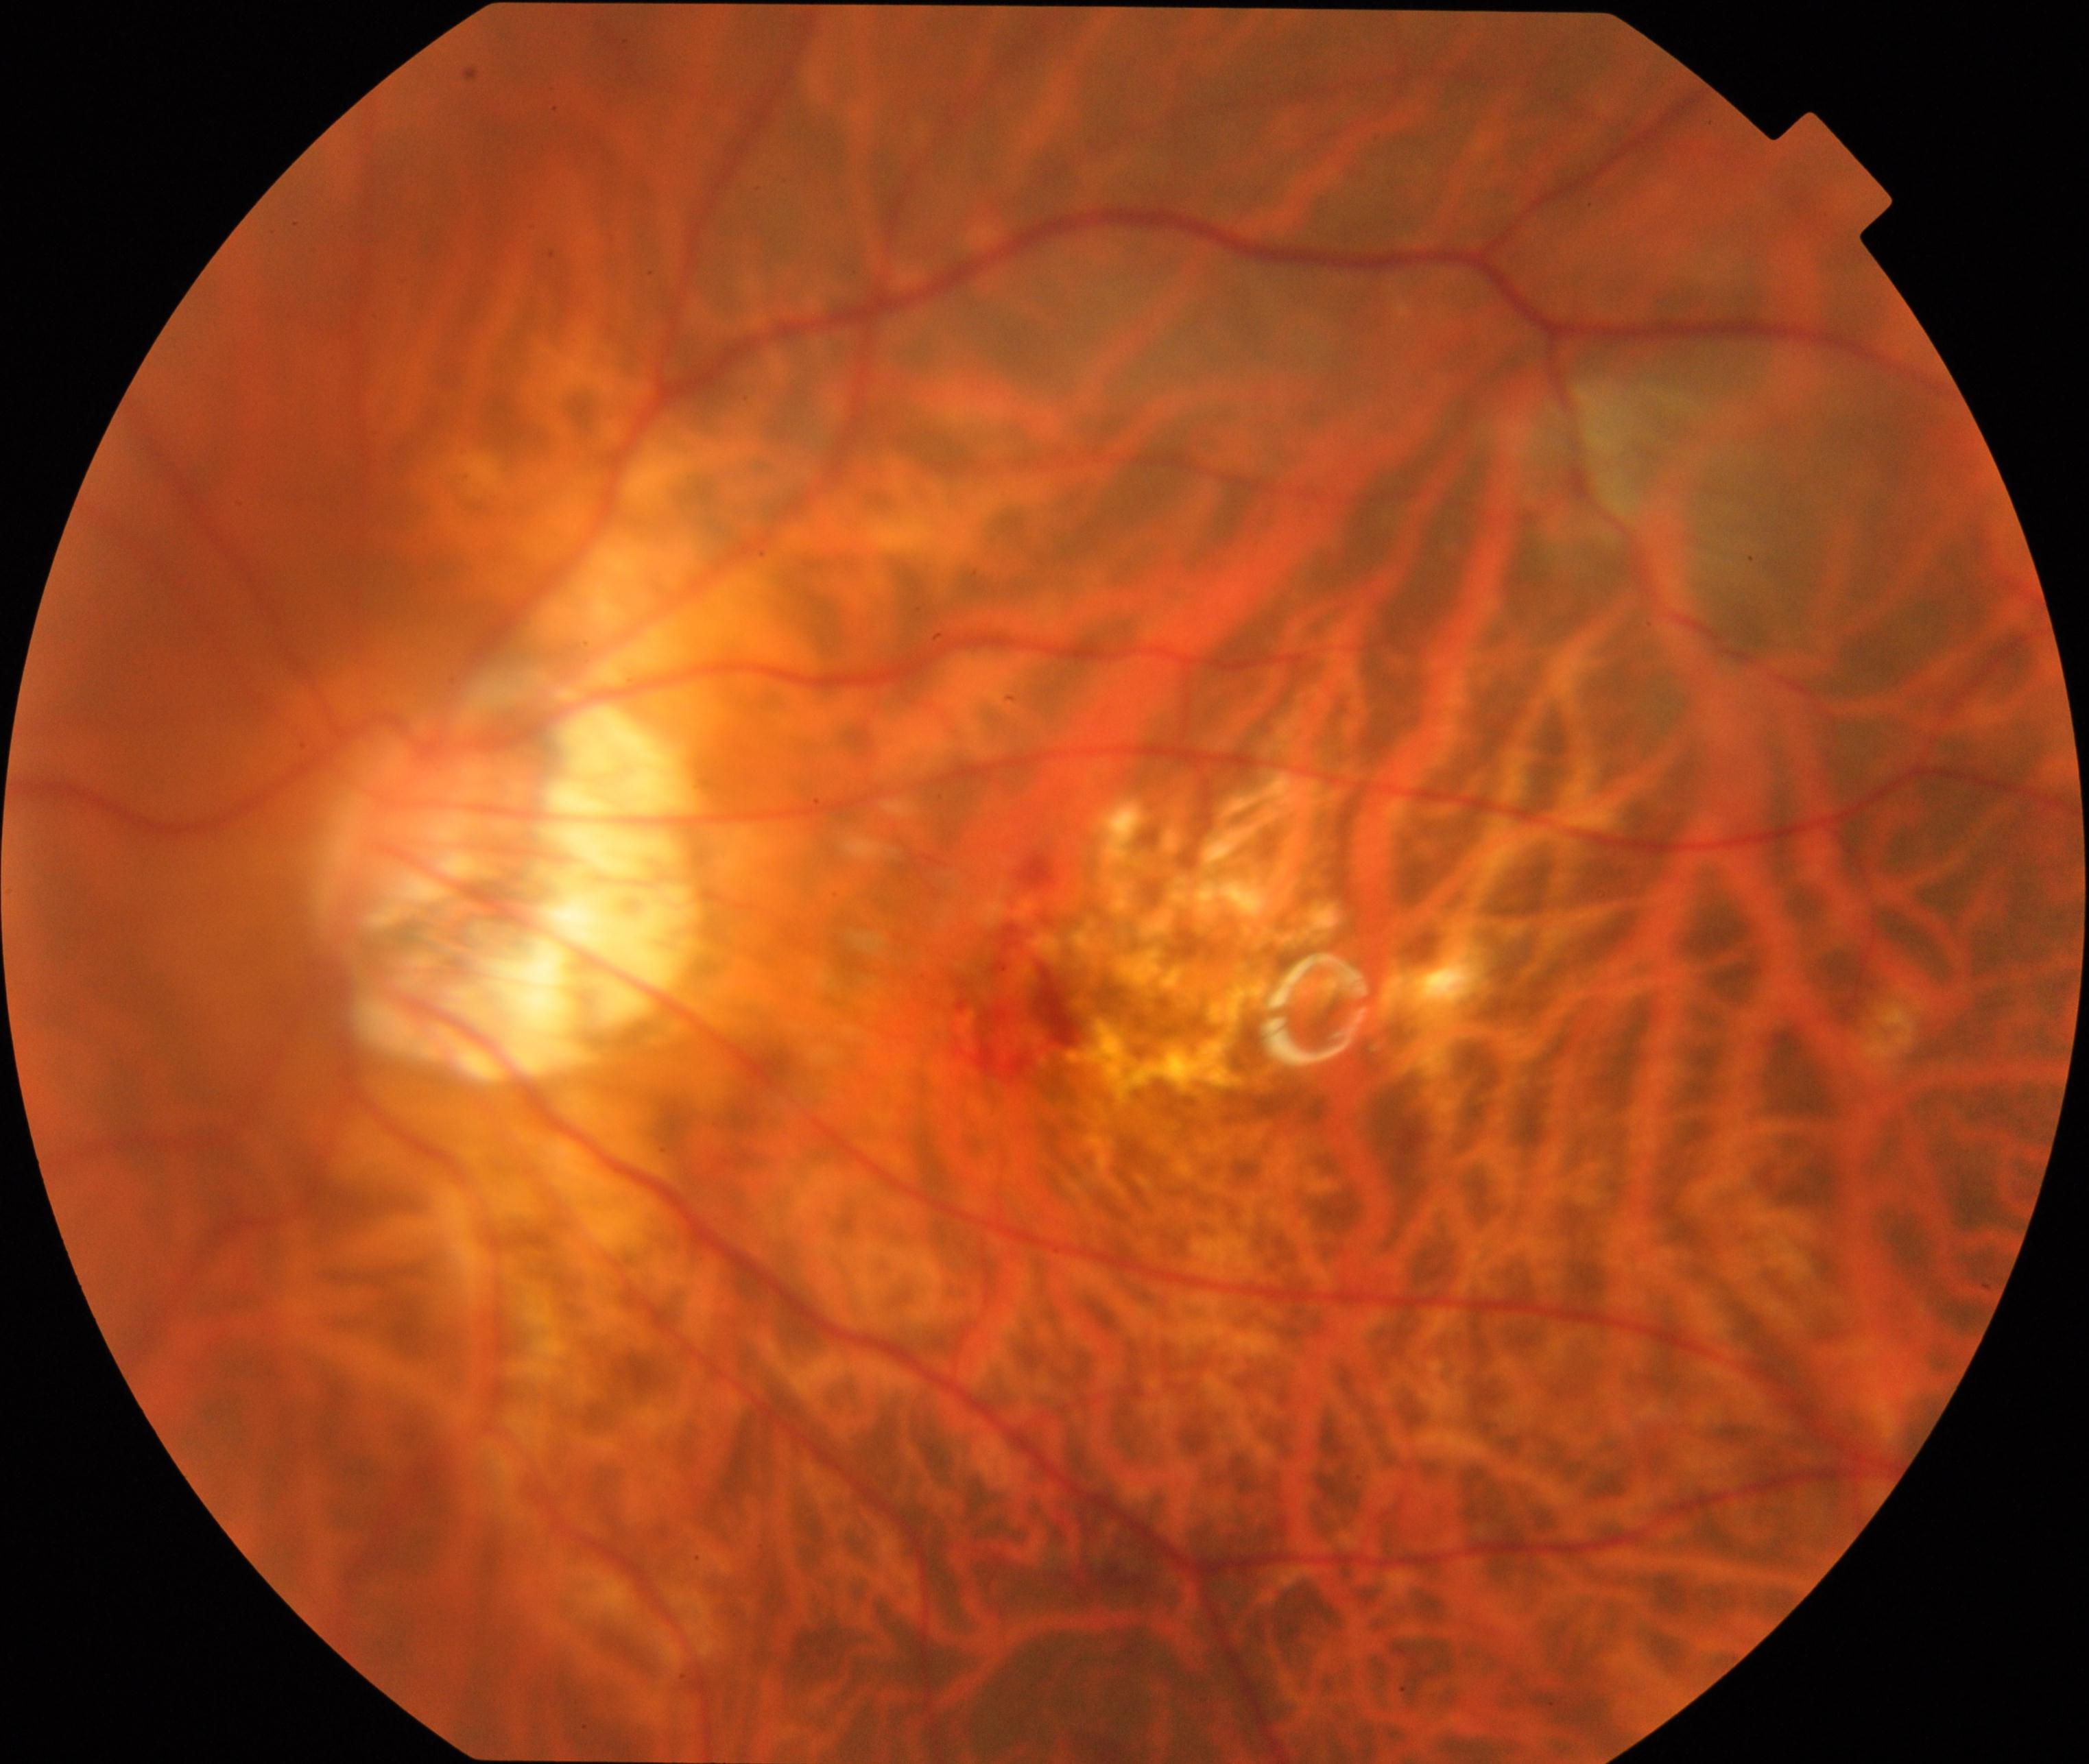
Appearance consistent with pathological myopia.